NIDEK AFC-230, nonmydriatic, color fundus photograph.
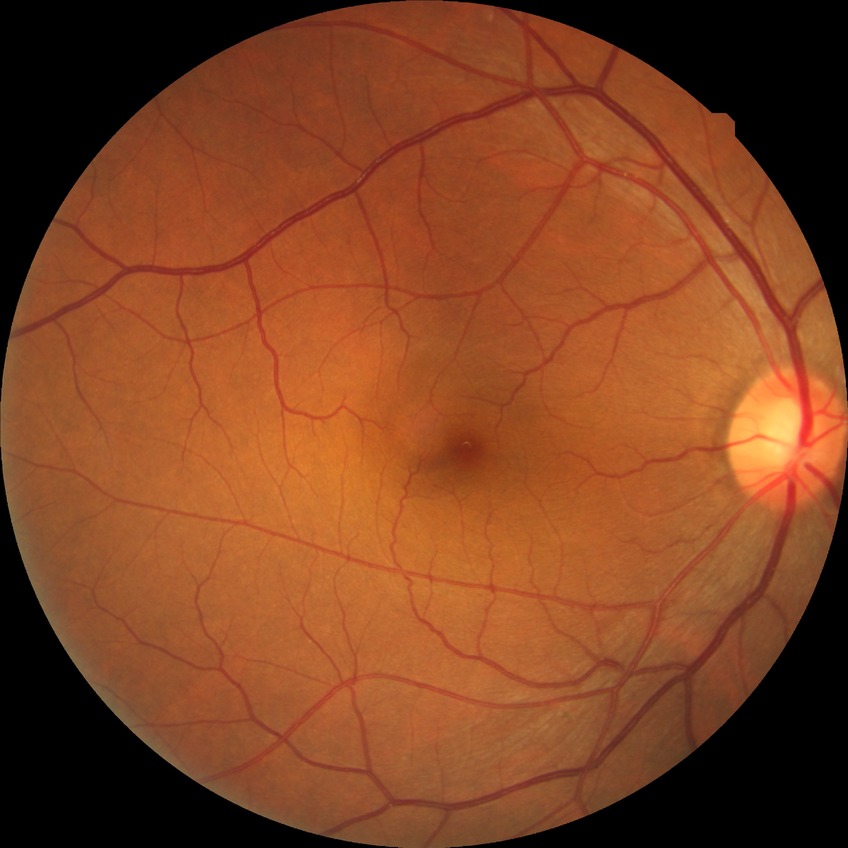

  davis_grade: no diabetic retinopathy